2352x1568. 45° field of view
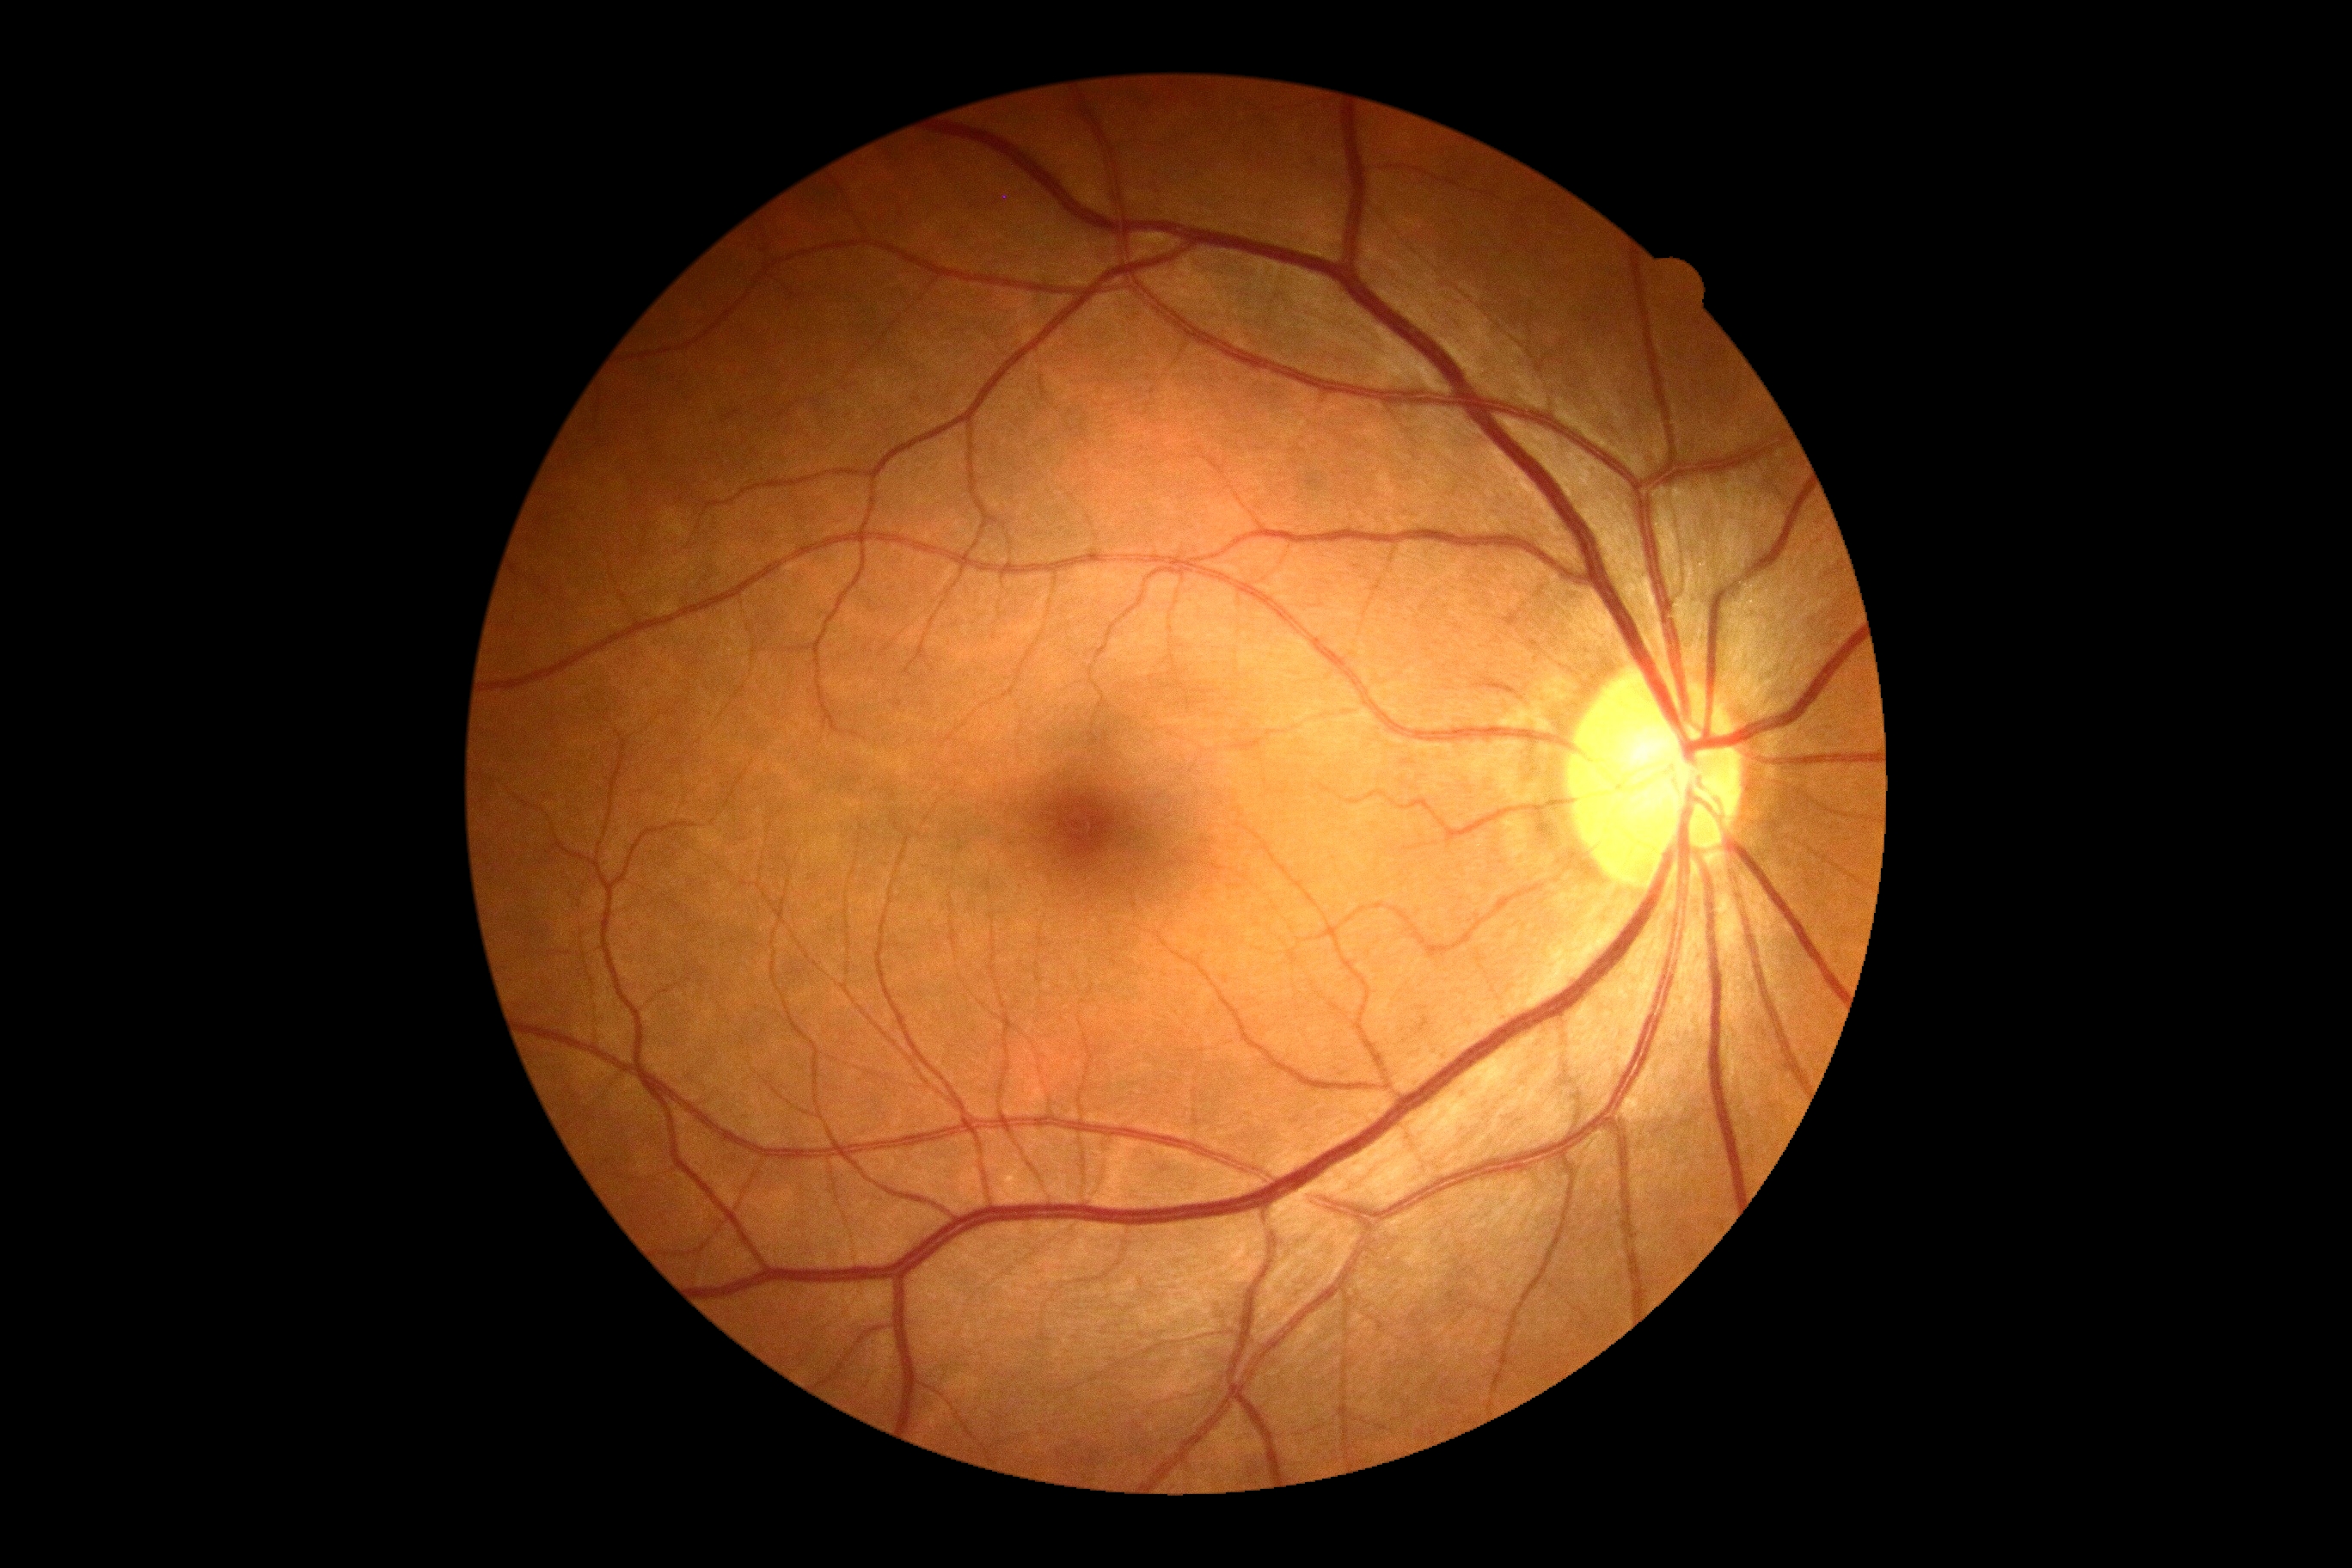
Diabetic retinopathy (DR): no apparent diabetic retinopathy (grade 0).